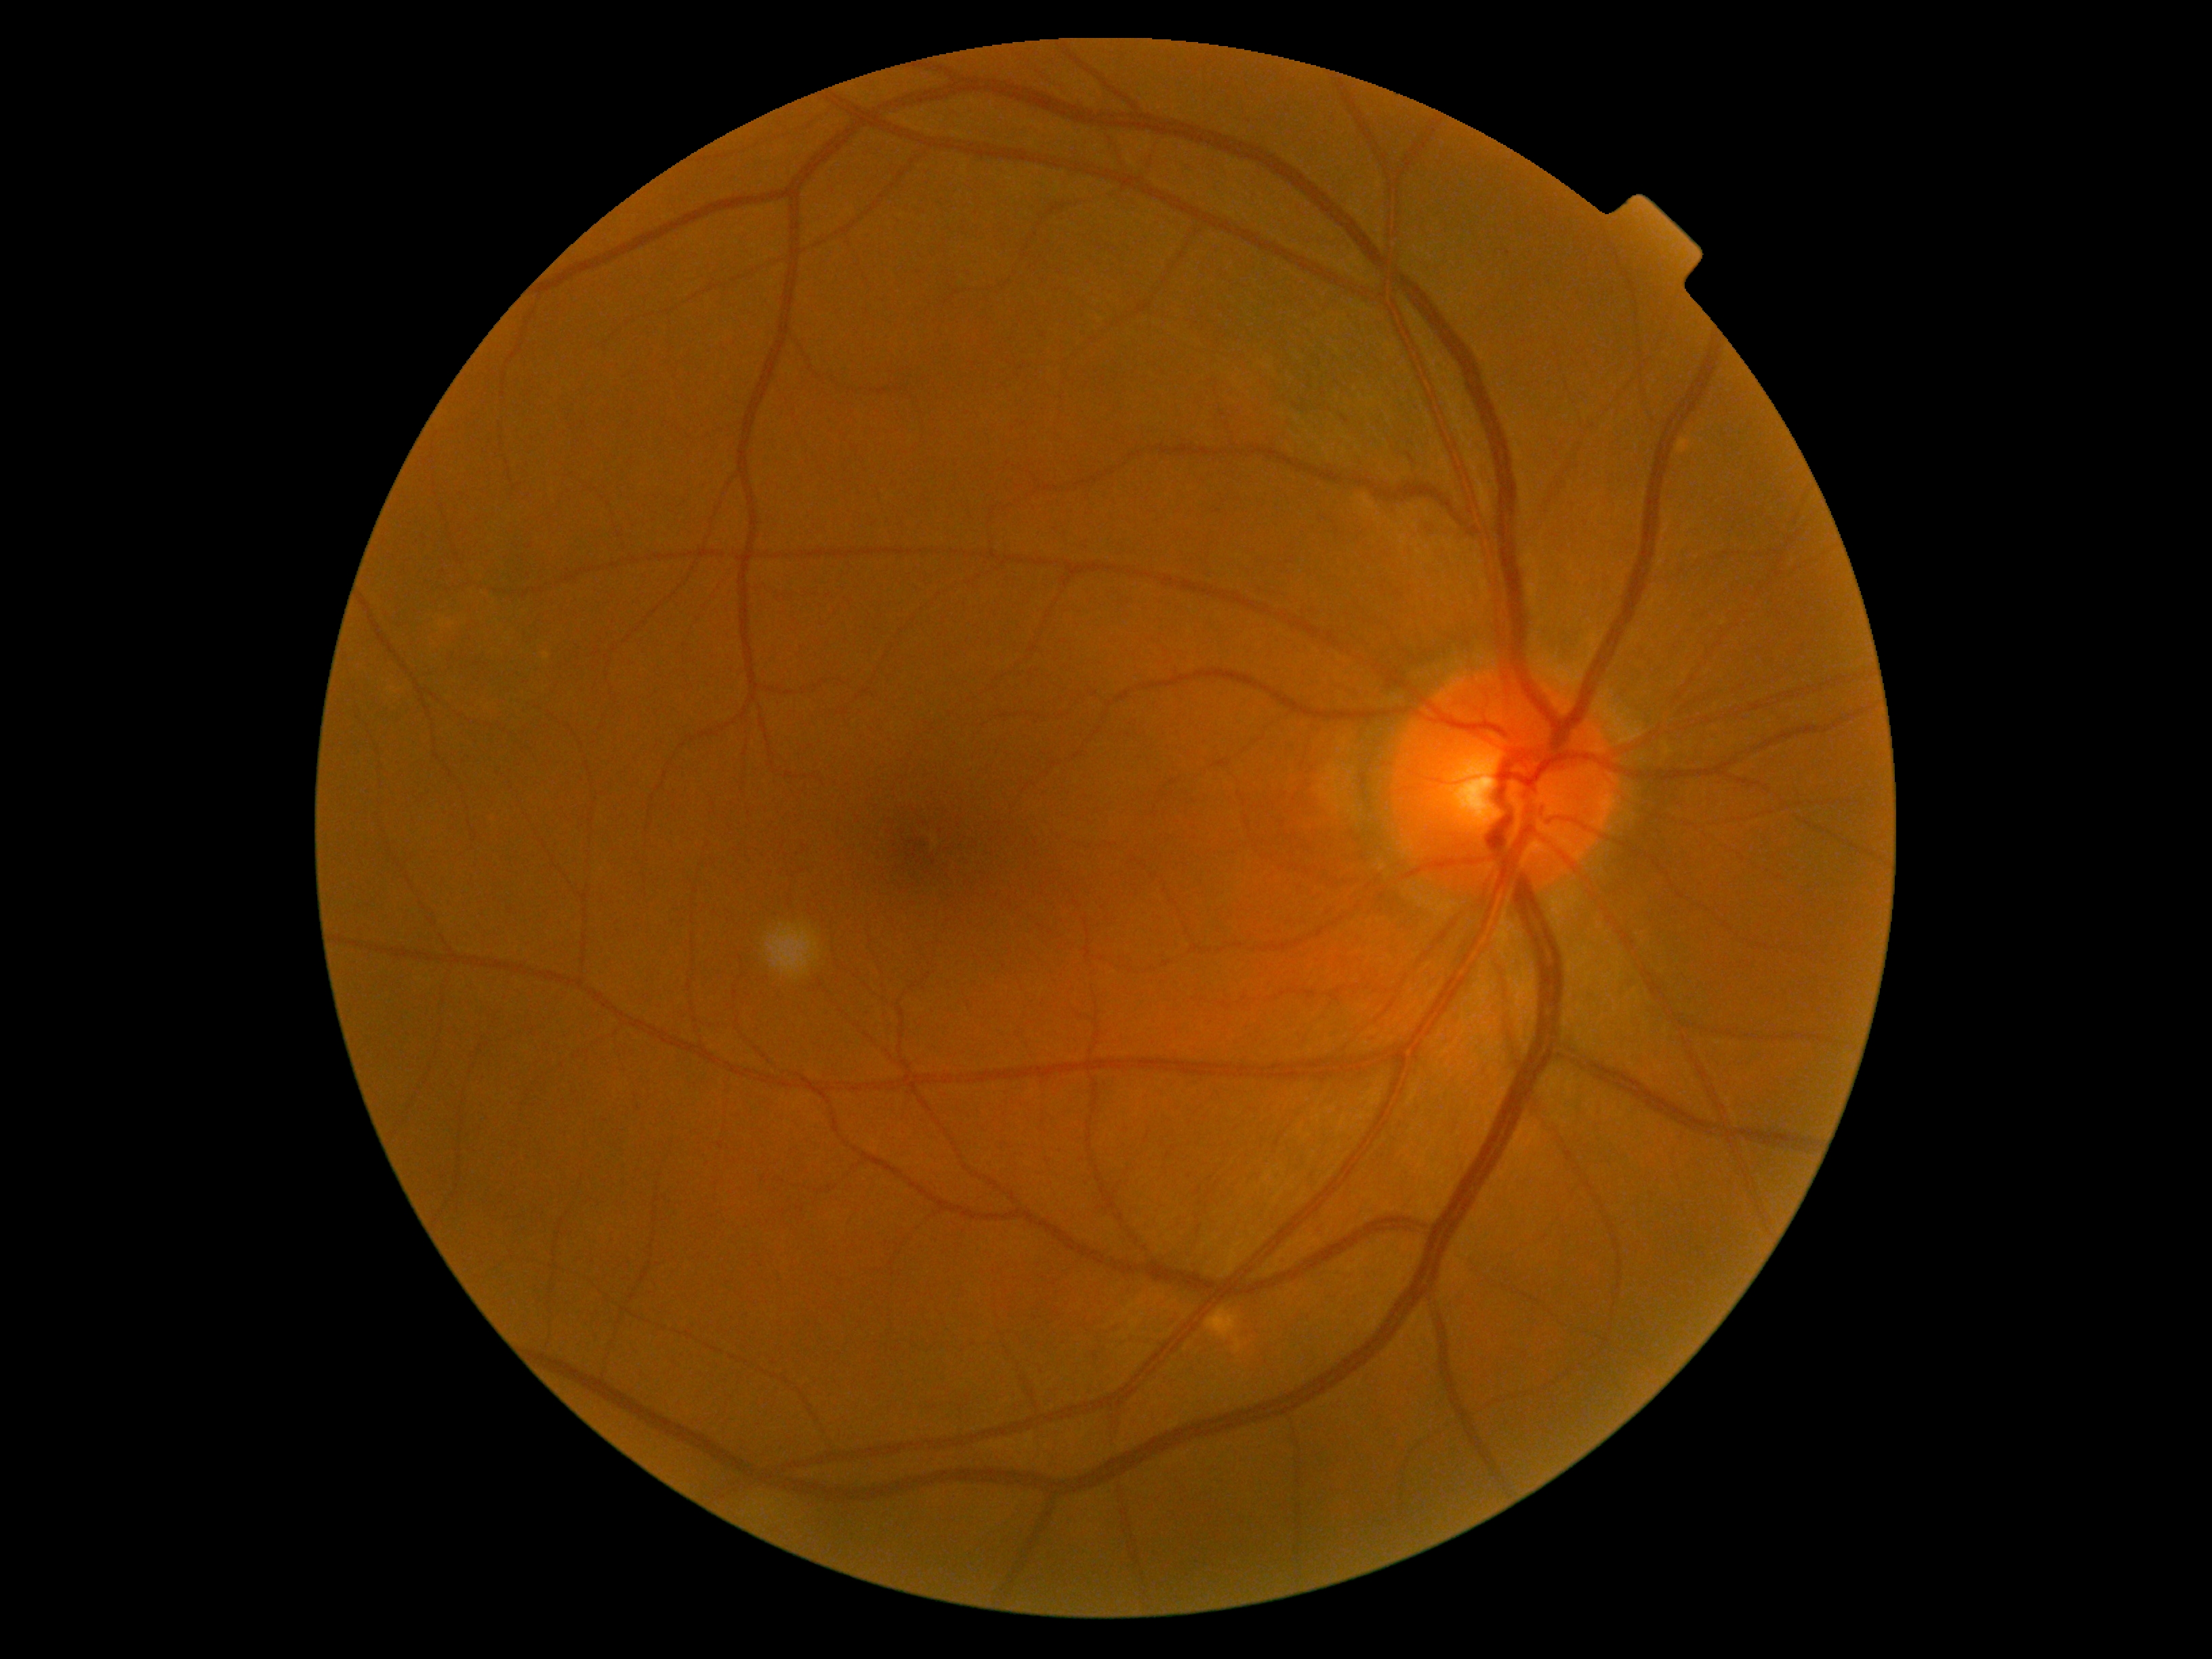

DR: 0 — no visible signs of diabetic retinopathy.